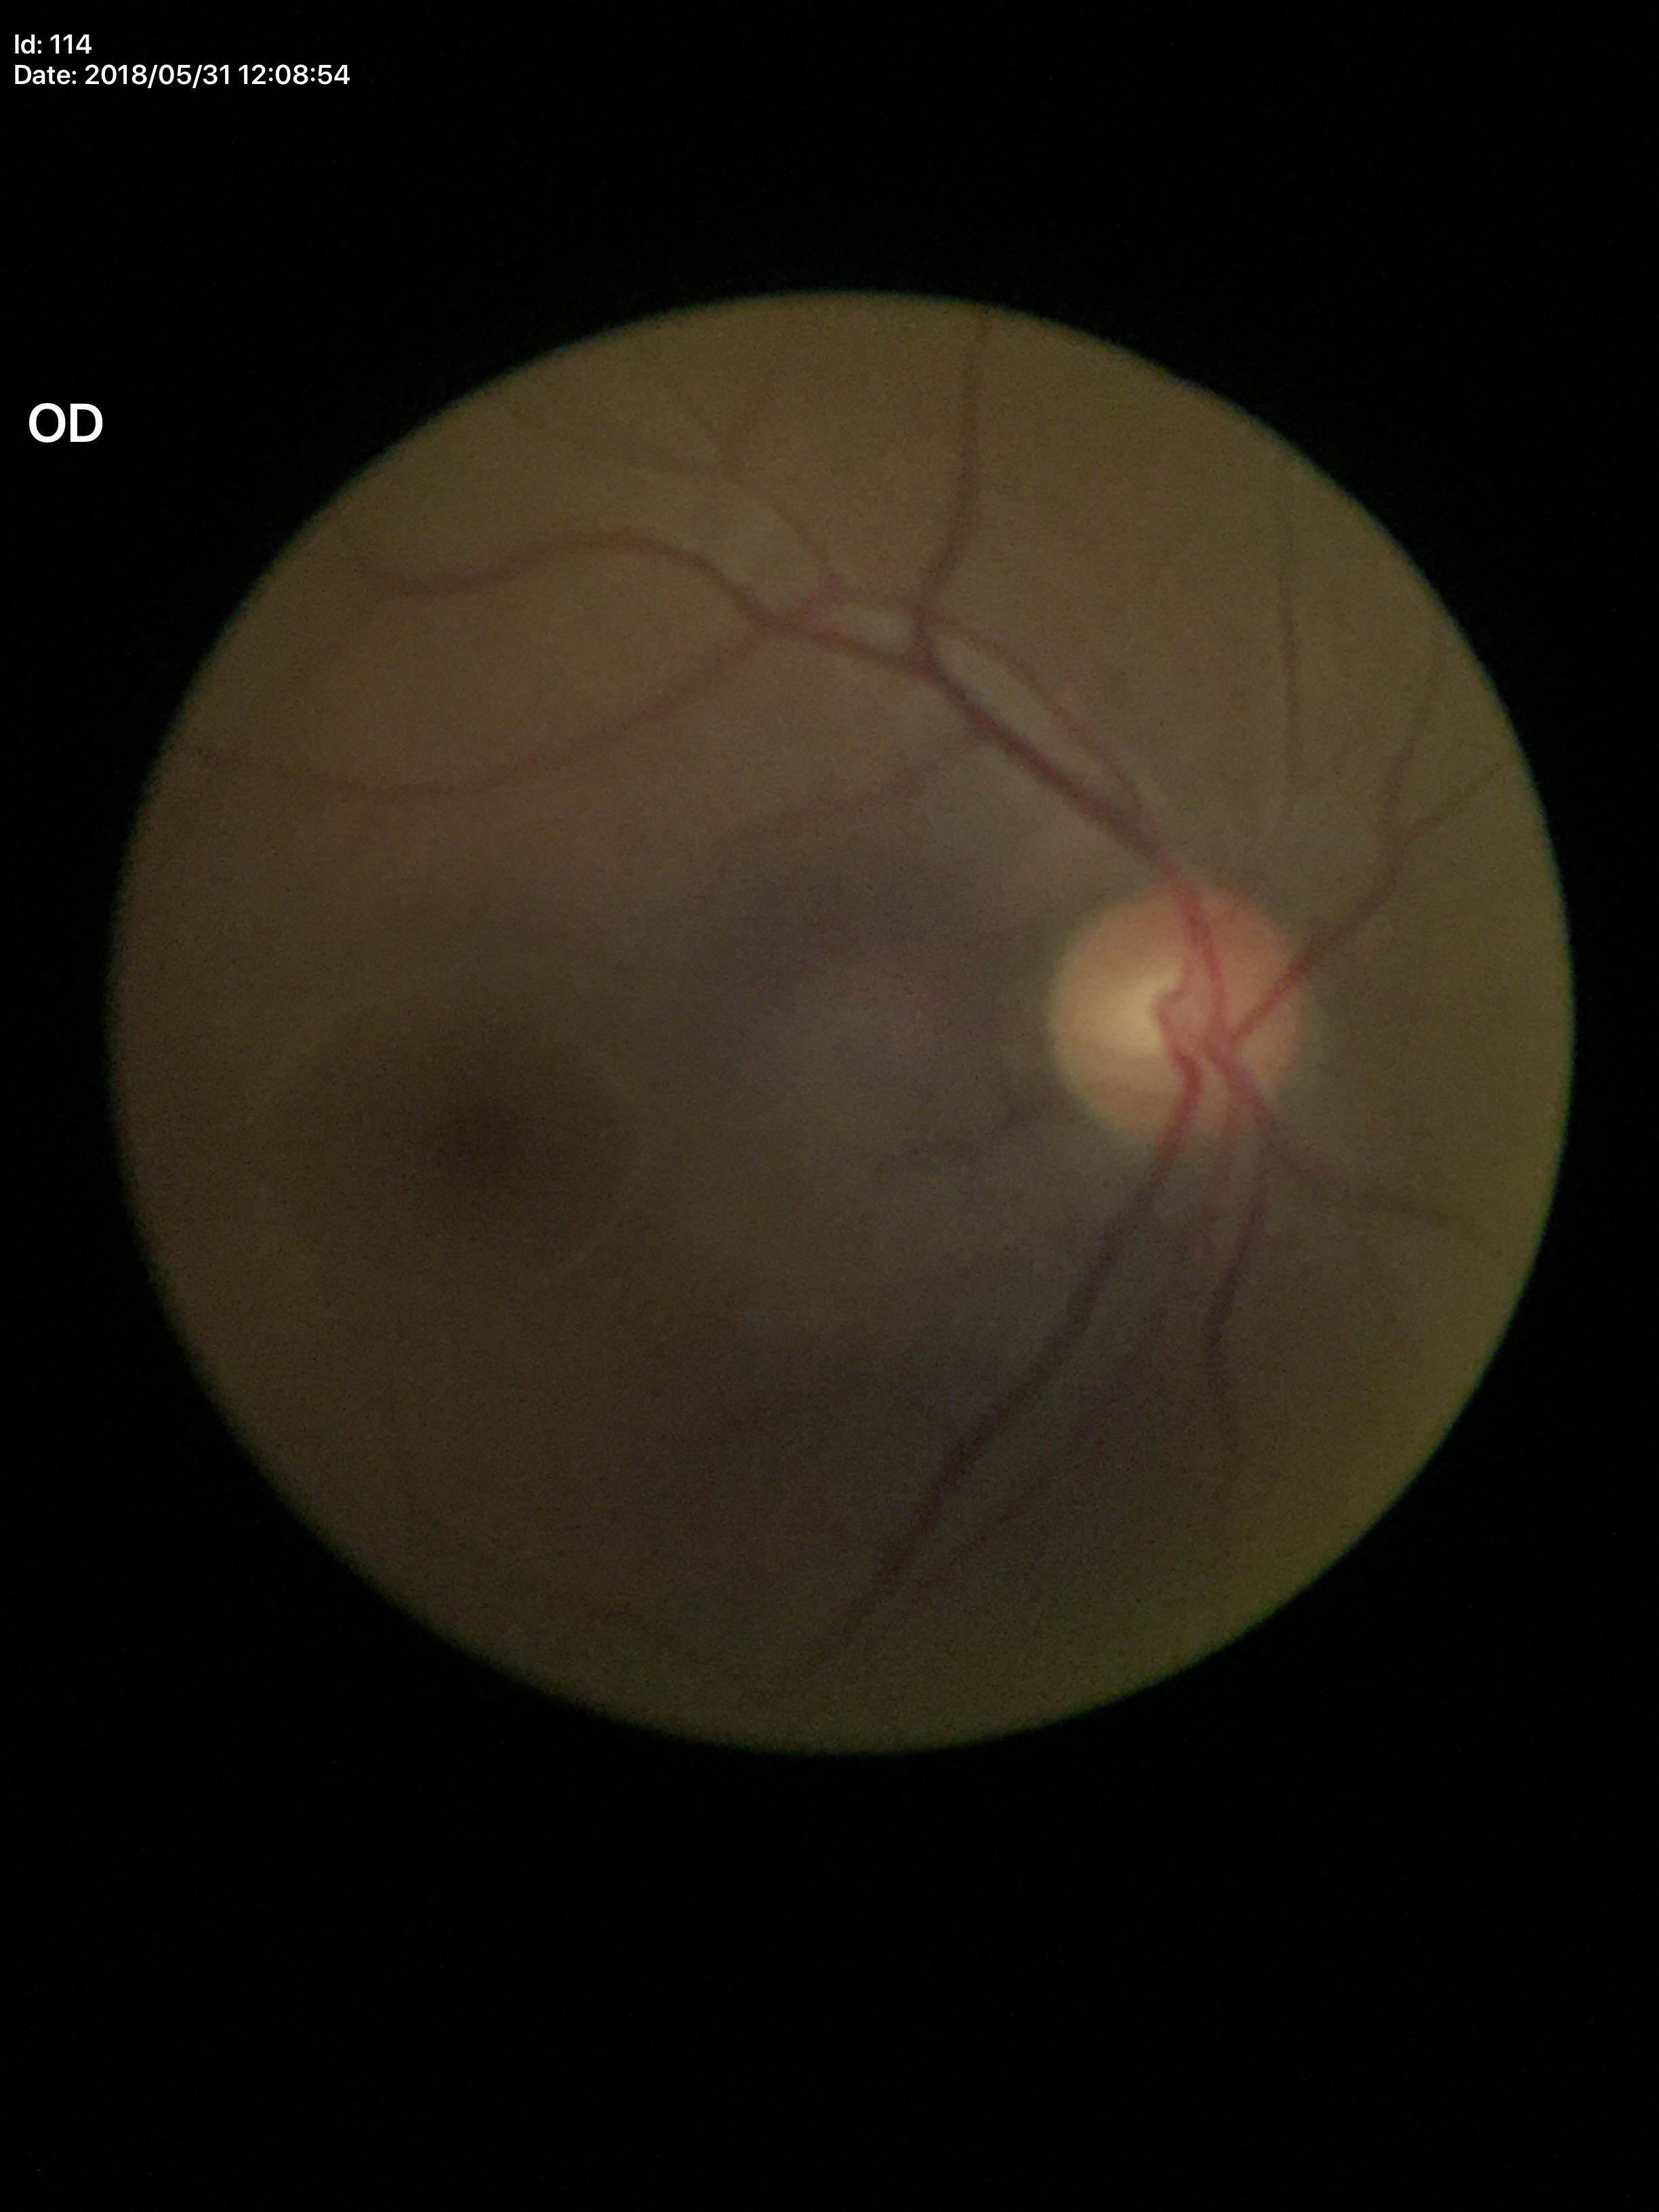 VCDR: 0.52; Glaucoma evaluation: no suspicious findings (1 of 5 graders flagged glaucoma suspect); HCDR: 0.52.